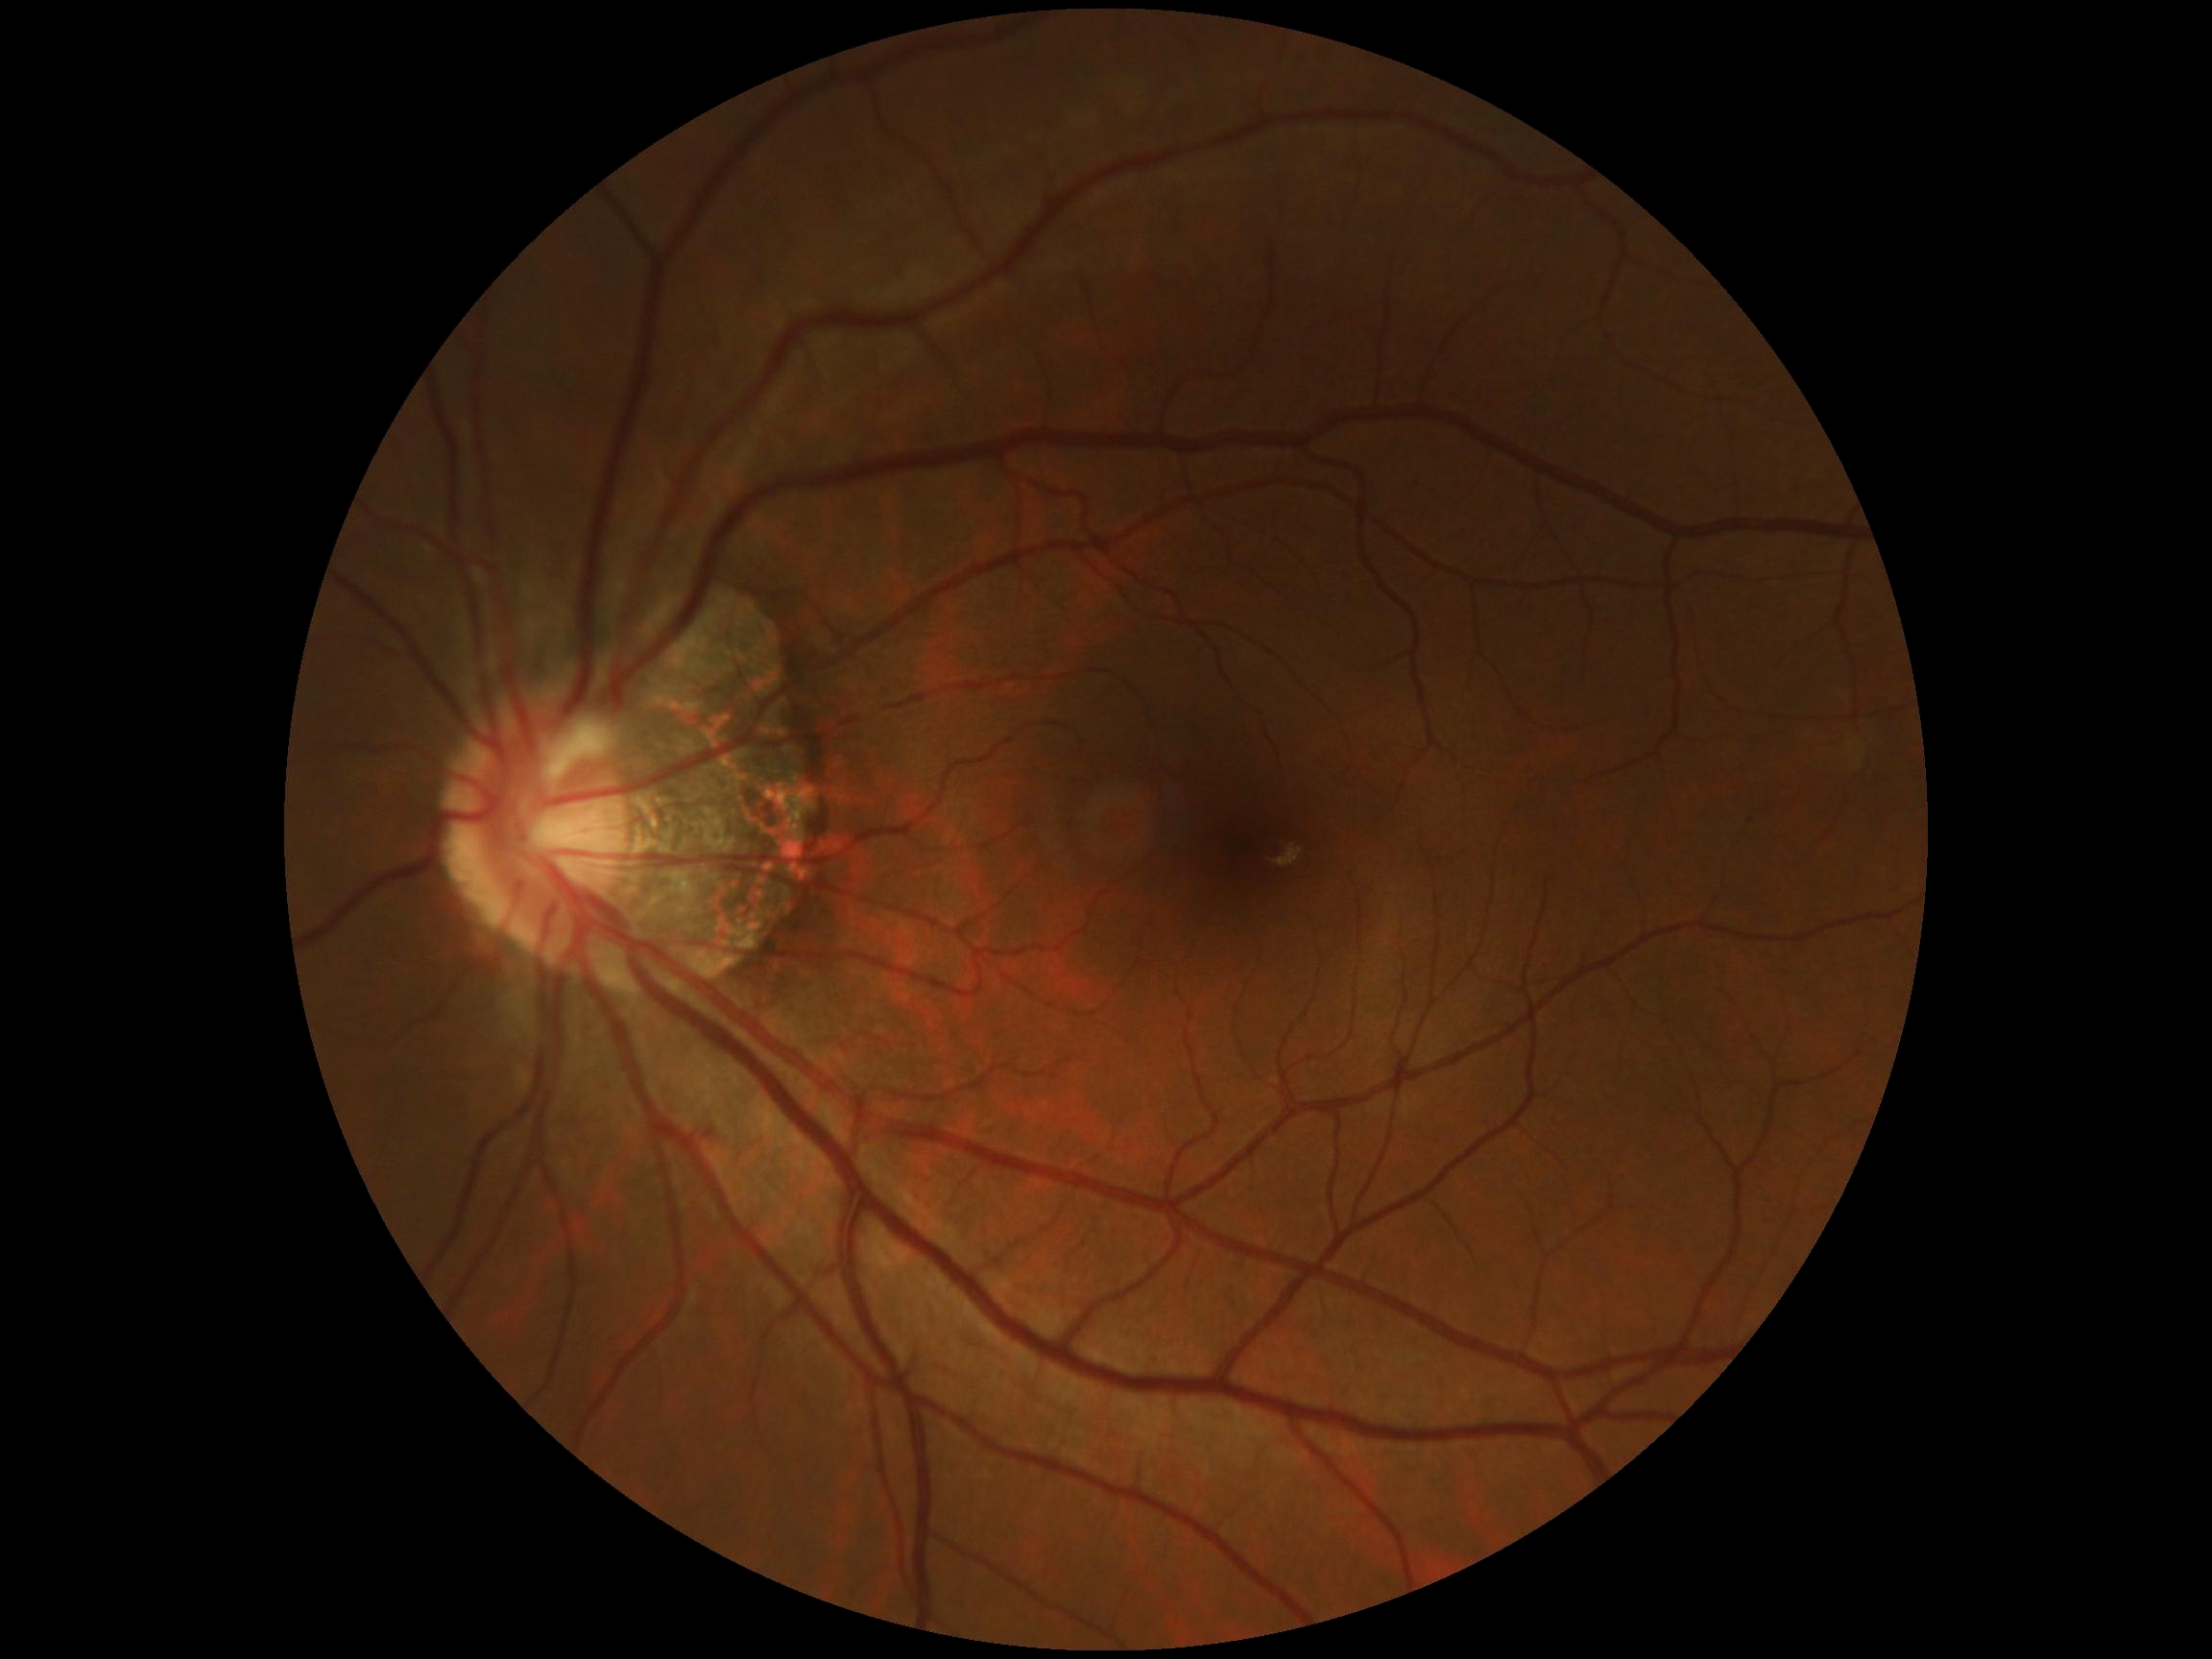 No apparent diabetic retinopathy. Diabetic retinopathy is grade 0 (no apparent retinopathy).